Wide-field fundus photograph of an infant:
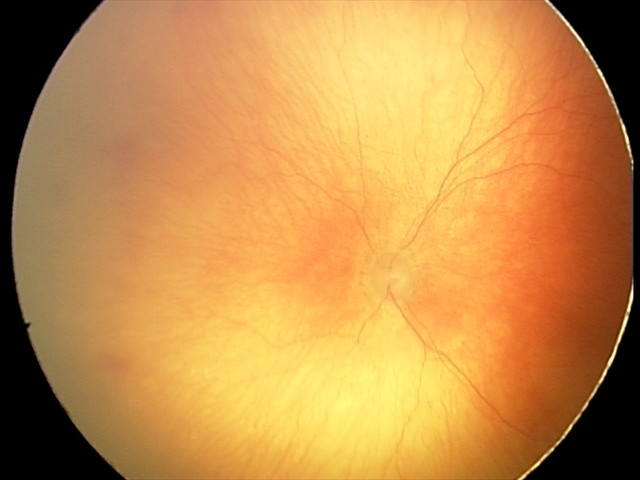
From an examination with diagnosis of aggressive retinopathy of prematurity (A-ROP).
Plus disease present.